Graded on the modified Davis scale — 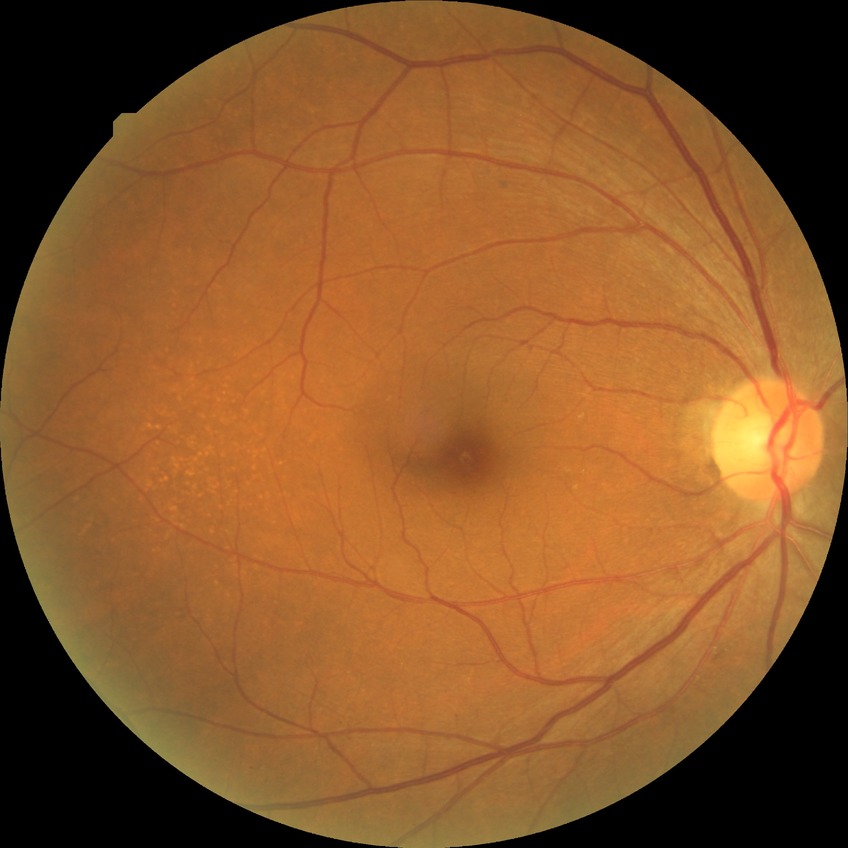   dr_impression: no DR findings
  davis_grade: NDR